Modified Davis grading. Acquired with a NIDEK AFC-230.
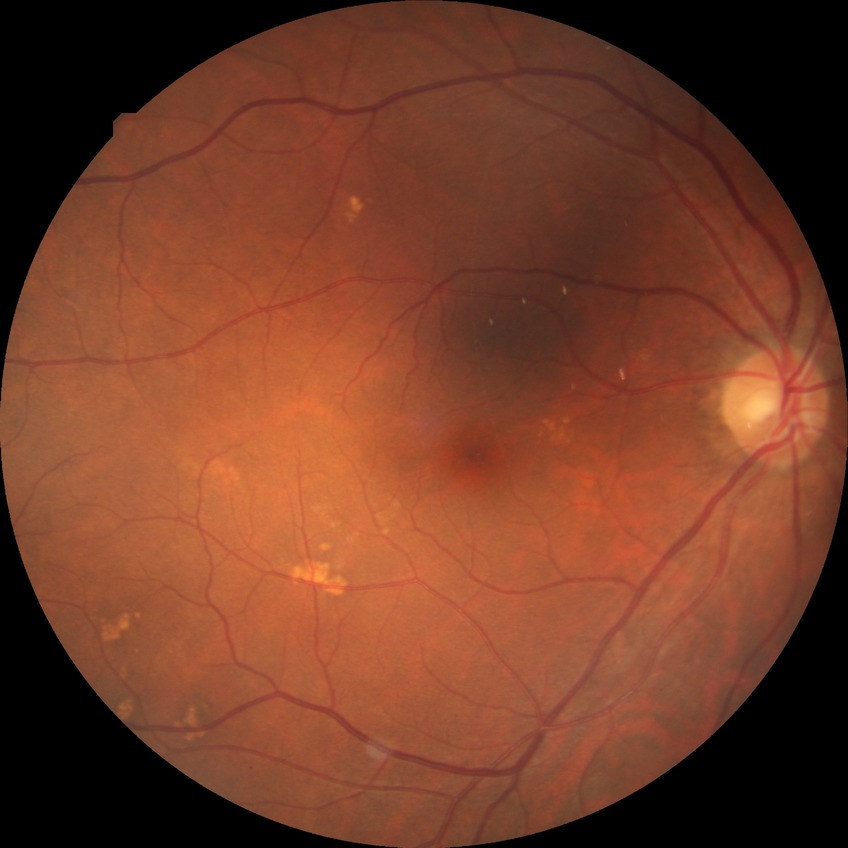
DR stage: SDR.